45-degree field of view. 2352x1568. Color fundus image — 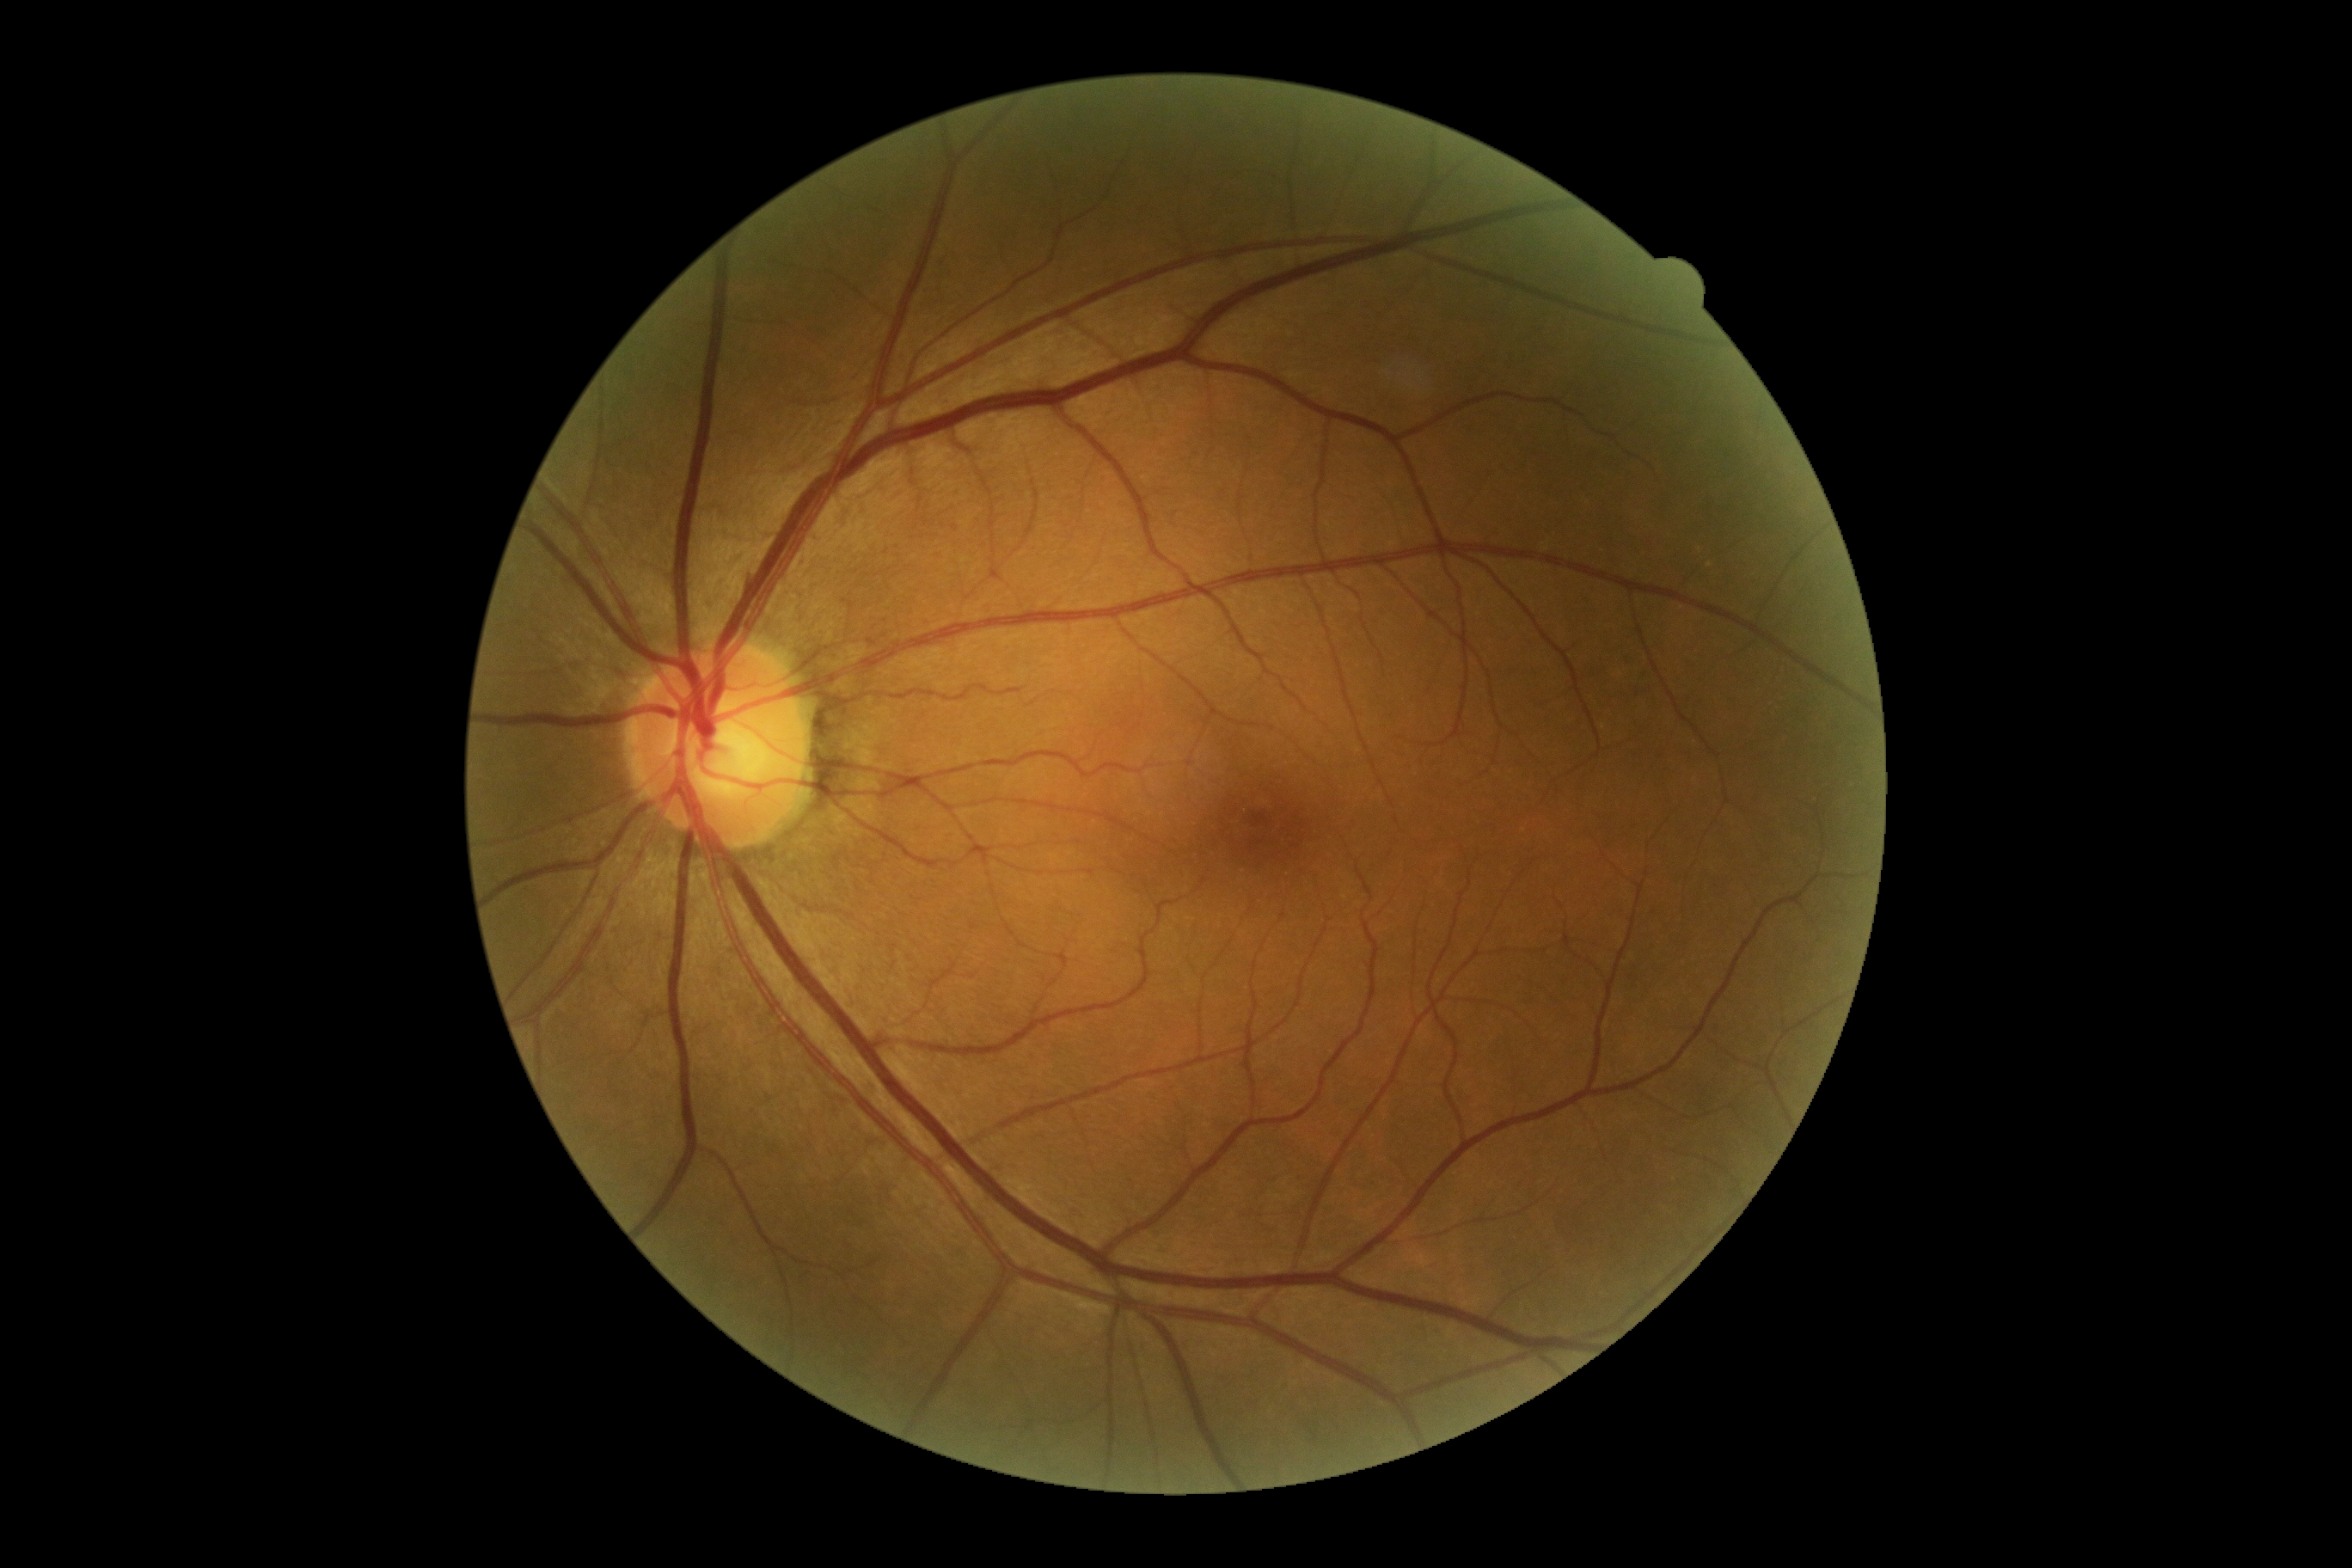
Diabetic retinopathy severity: 0/4.